Color fundus image, 45° FOV.
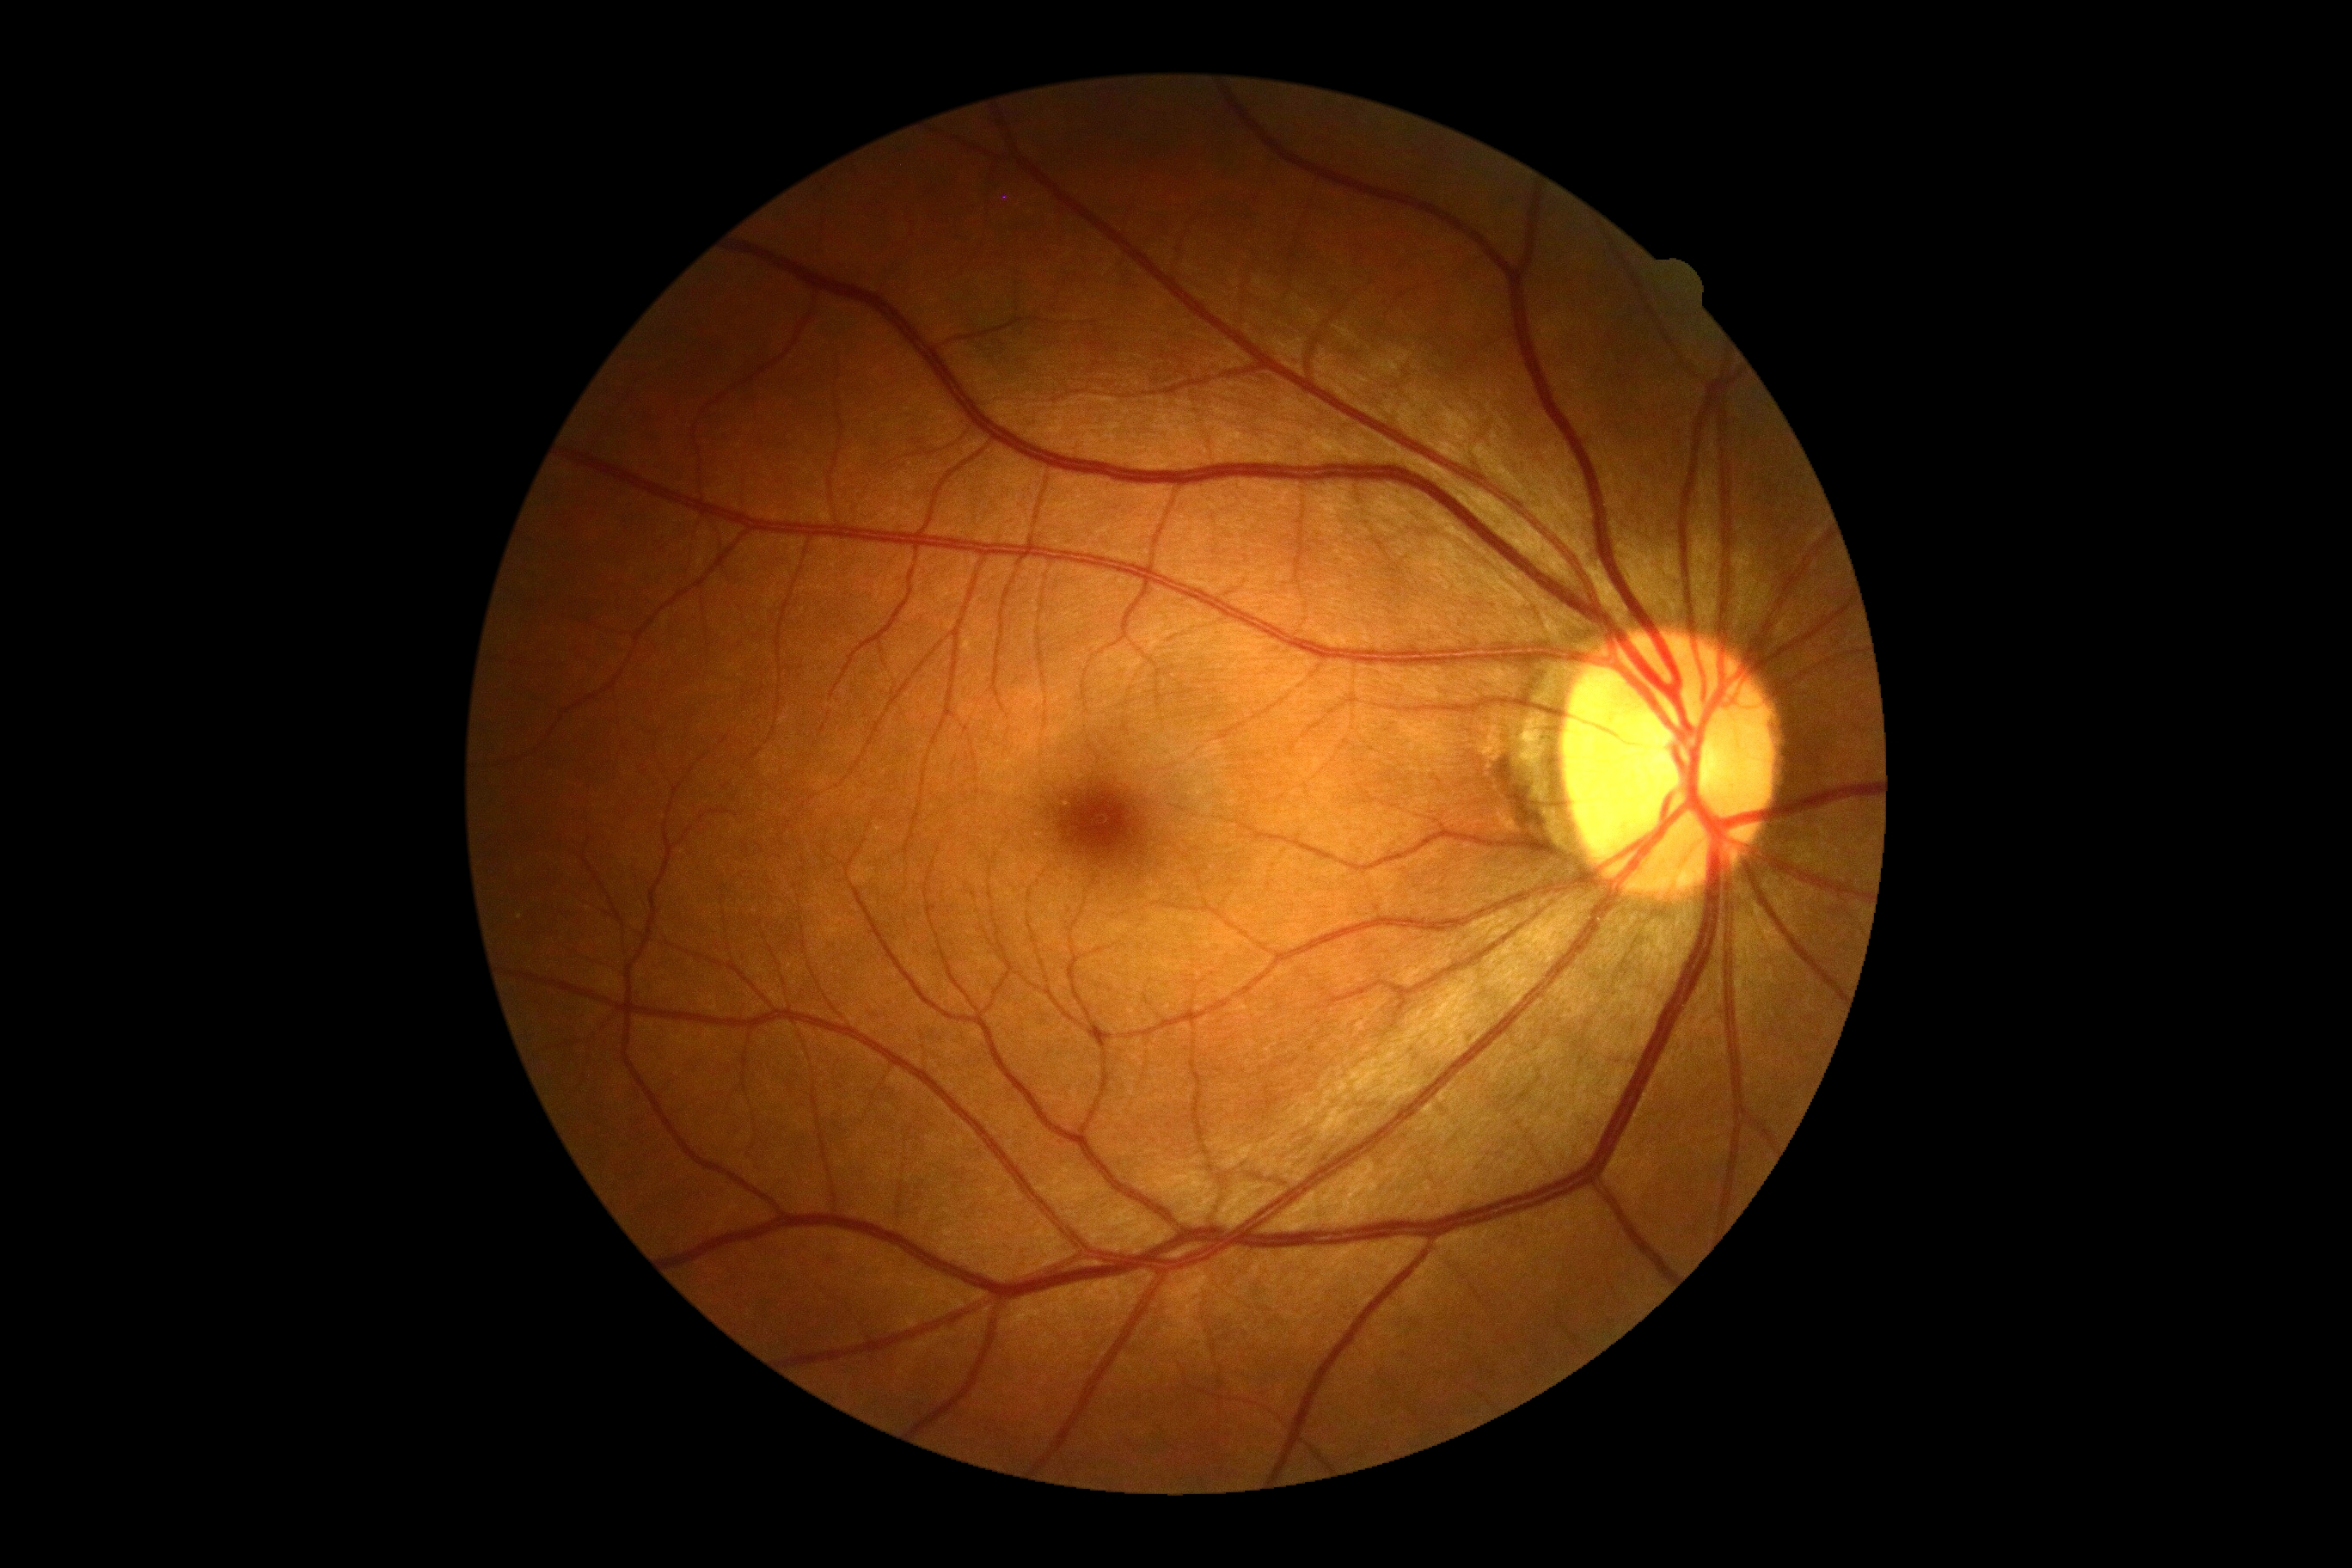 DR is 0/4. No signs of diabetic retinopathy.